2048x1536:
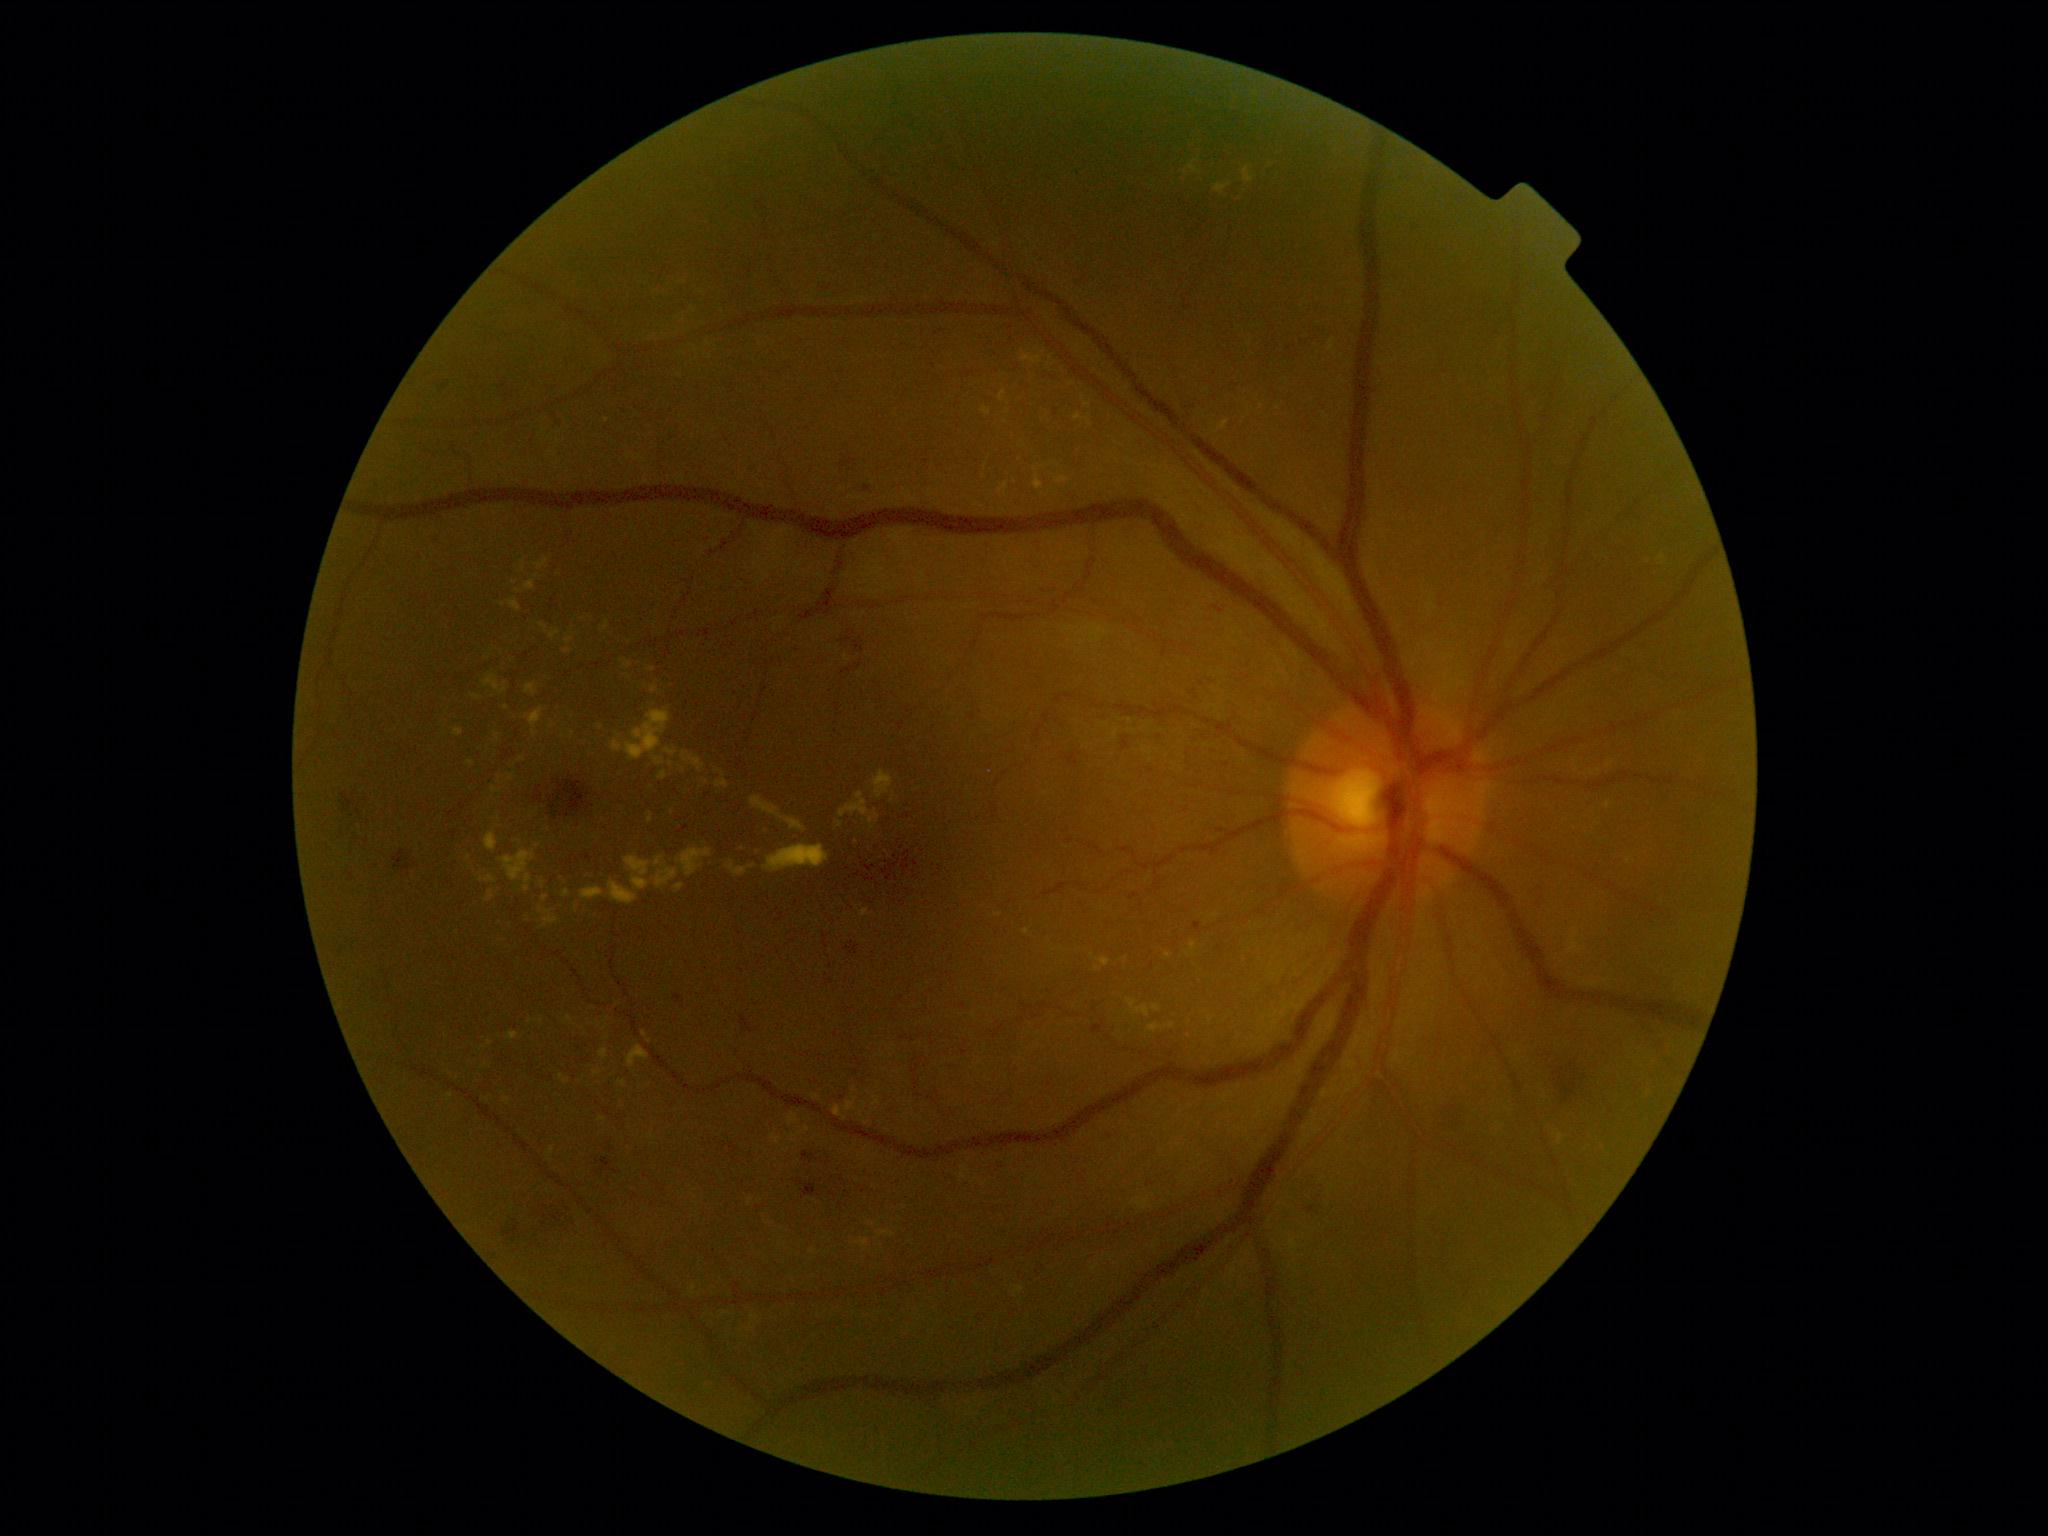 {"partial": true, "dr_grade": 2, "dr_grade_name": "moderate NPDR", "lesions": {"ex": [[1165, 1022, 1175, 1029], [624, 662, 633, 670], [627, 1045, 650, 1068], [1034, 474, 1044, 491], [763, 845, 829, 872], [1087, 418, 1091, 427], [790, 1133, 803, 1143], [1098, 958, 1111, 967], [1055, 477, 1069, 484], [1658, 556, 1665, 564], [1569, 928, 1582, 955]], "ex_small_approx": [[1092, 955], [672, 964], [499, 819], [1087, 405], [521, 760], [1071, 384], [807, 1129]]}}